Captured with the Clarity RetCam 3 (130° field of view) · wide-field fundus photograph from neonatal ROP screening · 640x480: 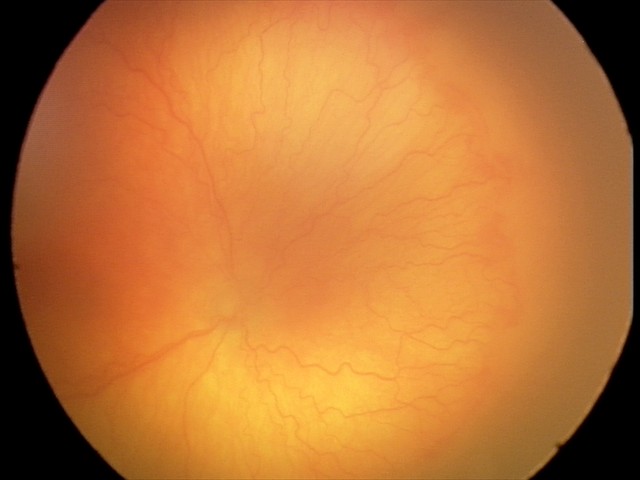

Plus form: present
diagnosis: aggressive retinopathy of prematurity (A-ROP)